Without pupil dilation: 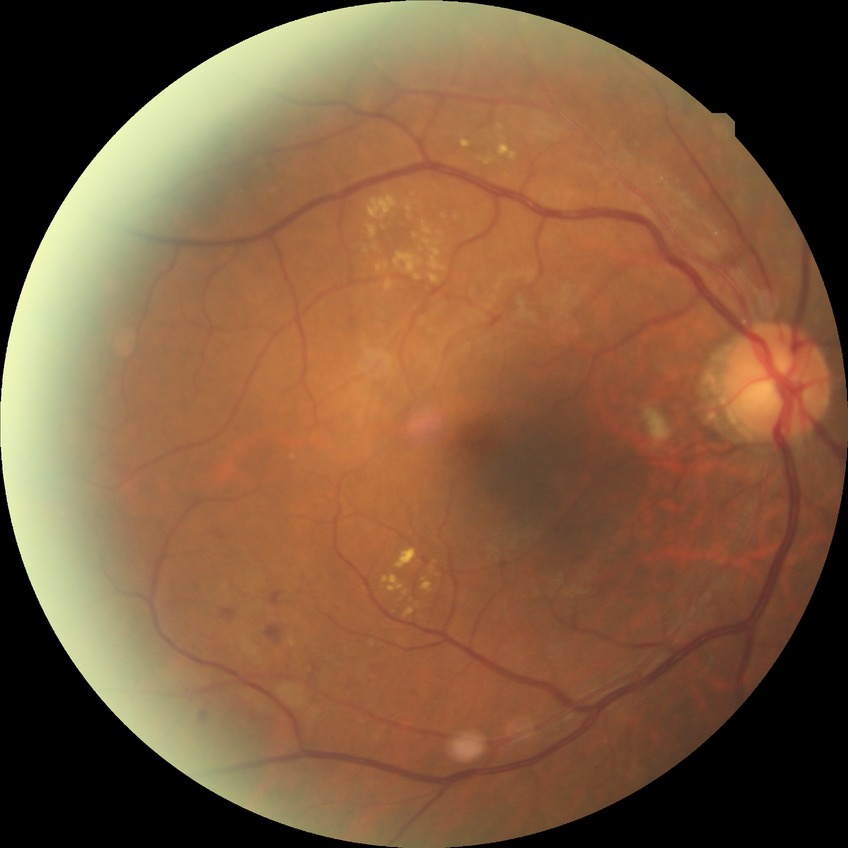

Davis grade is PPDR.